NIDEK AFC-230. Nonmydriatic.
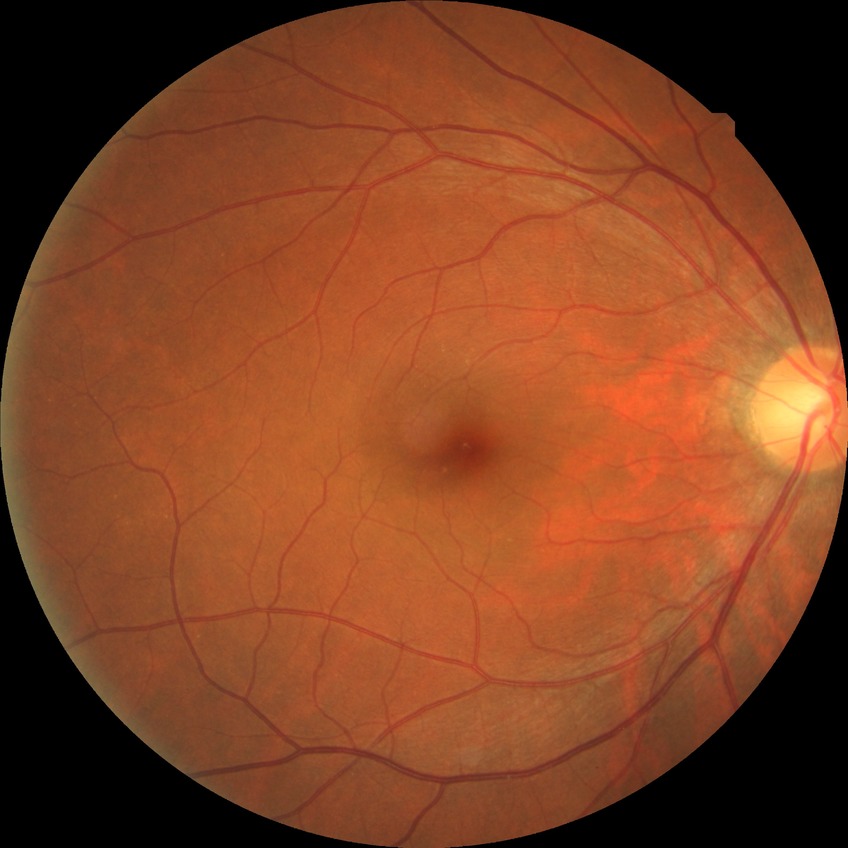
Diabetic retinopathy (DR) is NDR (no diabetic retinopathy).